Fundus photo — 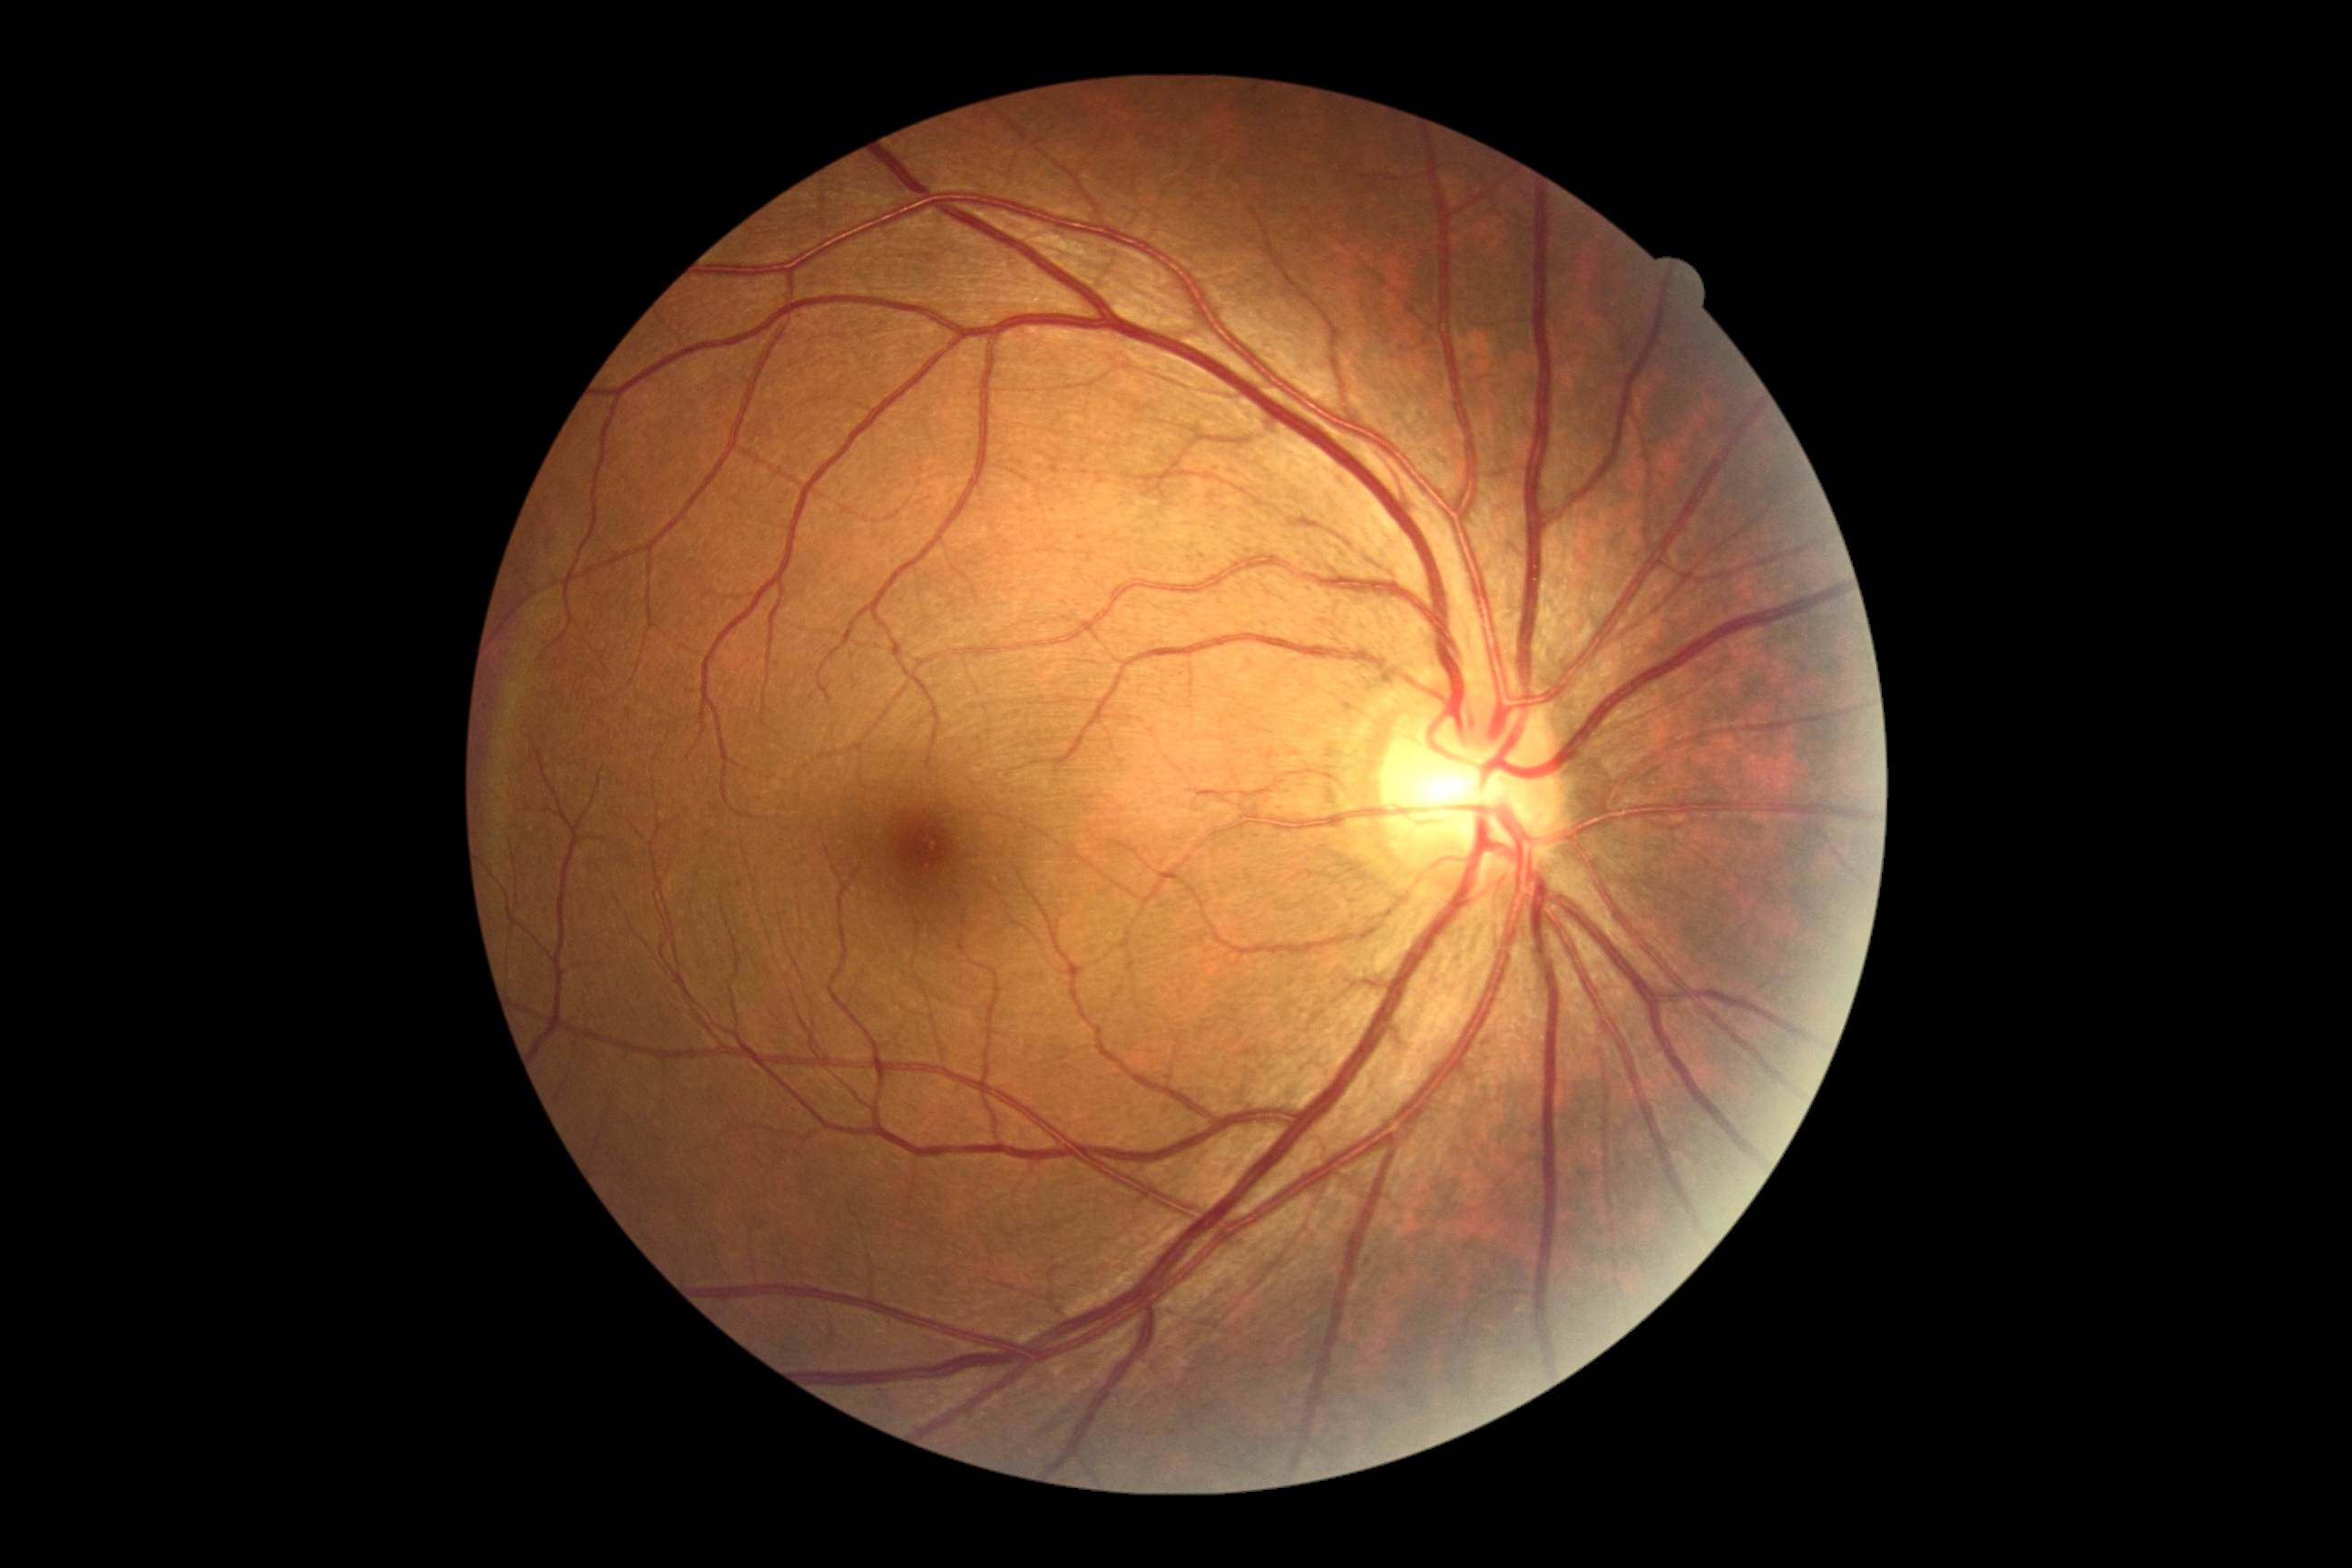
Diabetic retinopathy (DR) is 0/4.